640 by 480 pixels. Infant wide-field retinal image
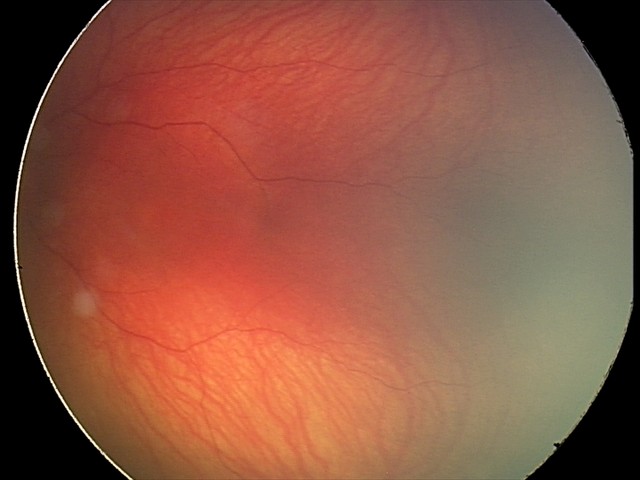

Screening examination with no abnormal retinal findings.